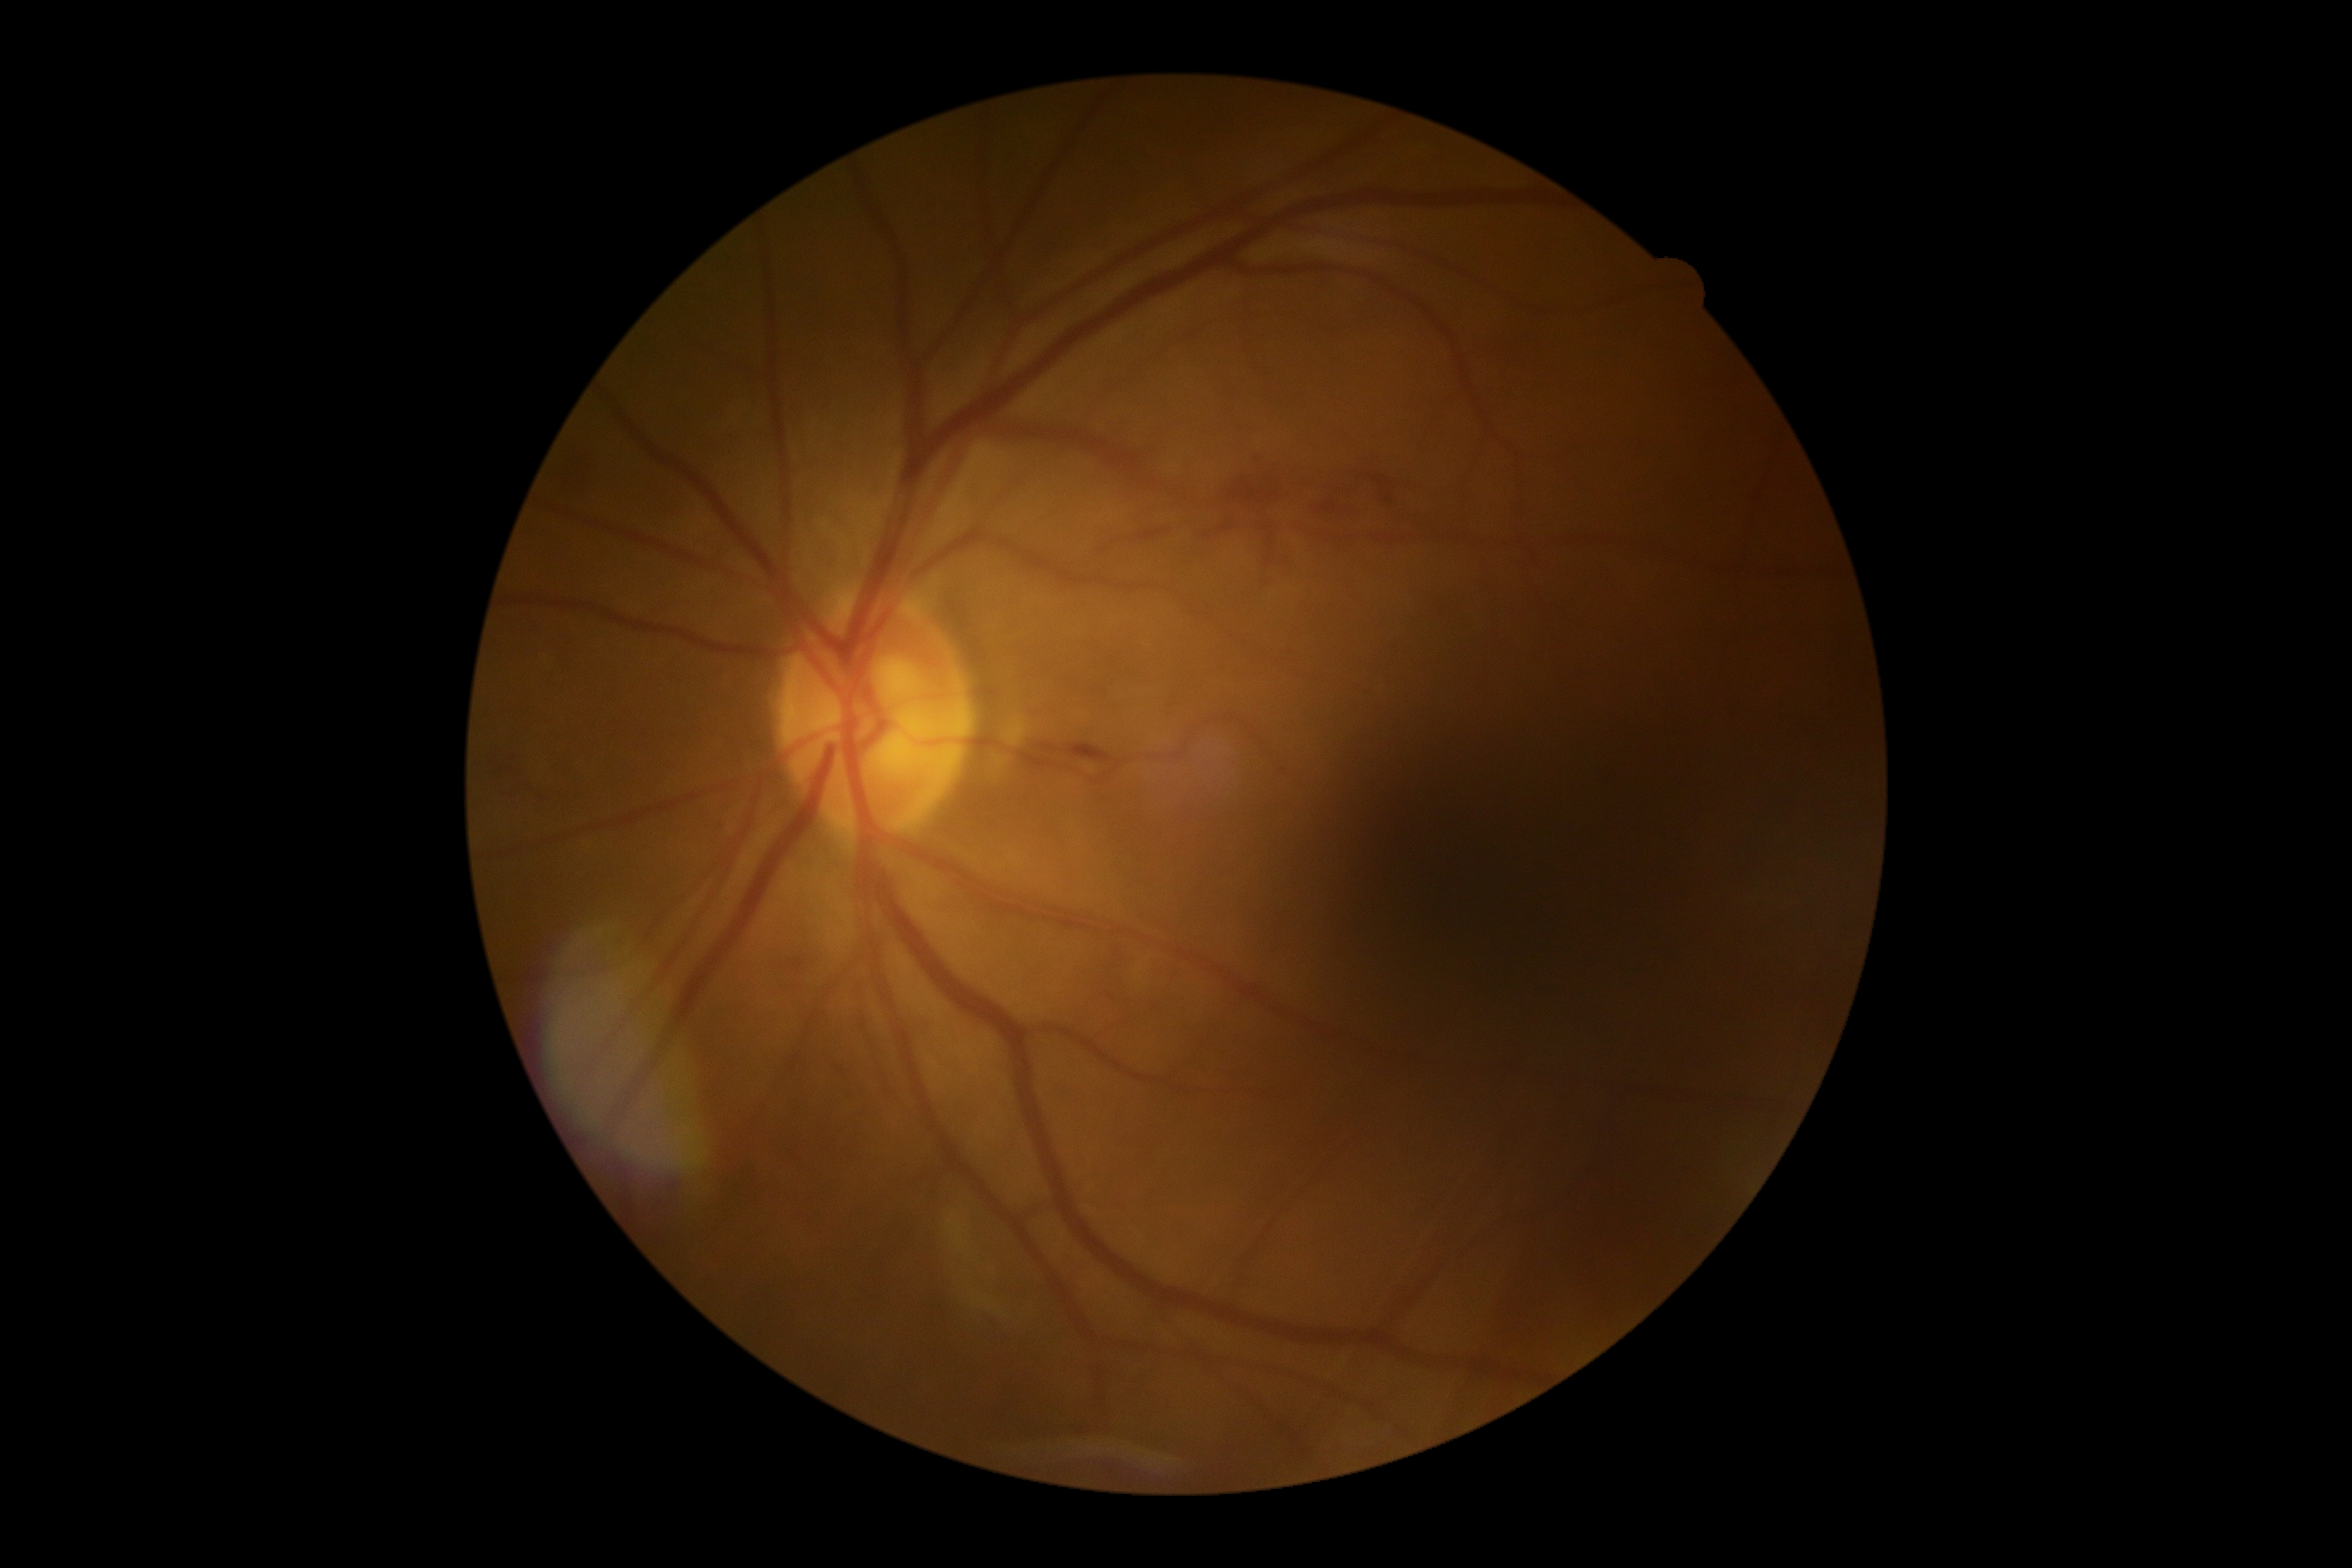

Diabetic retinopathy (DR): 2.